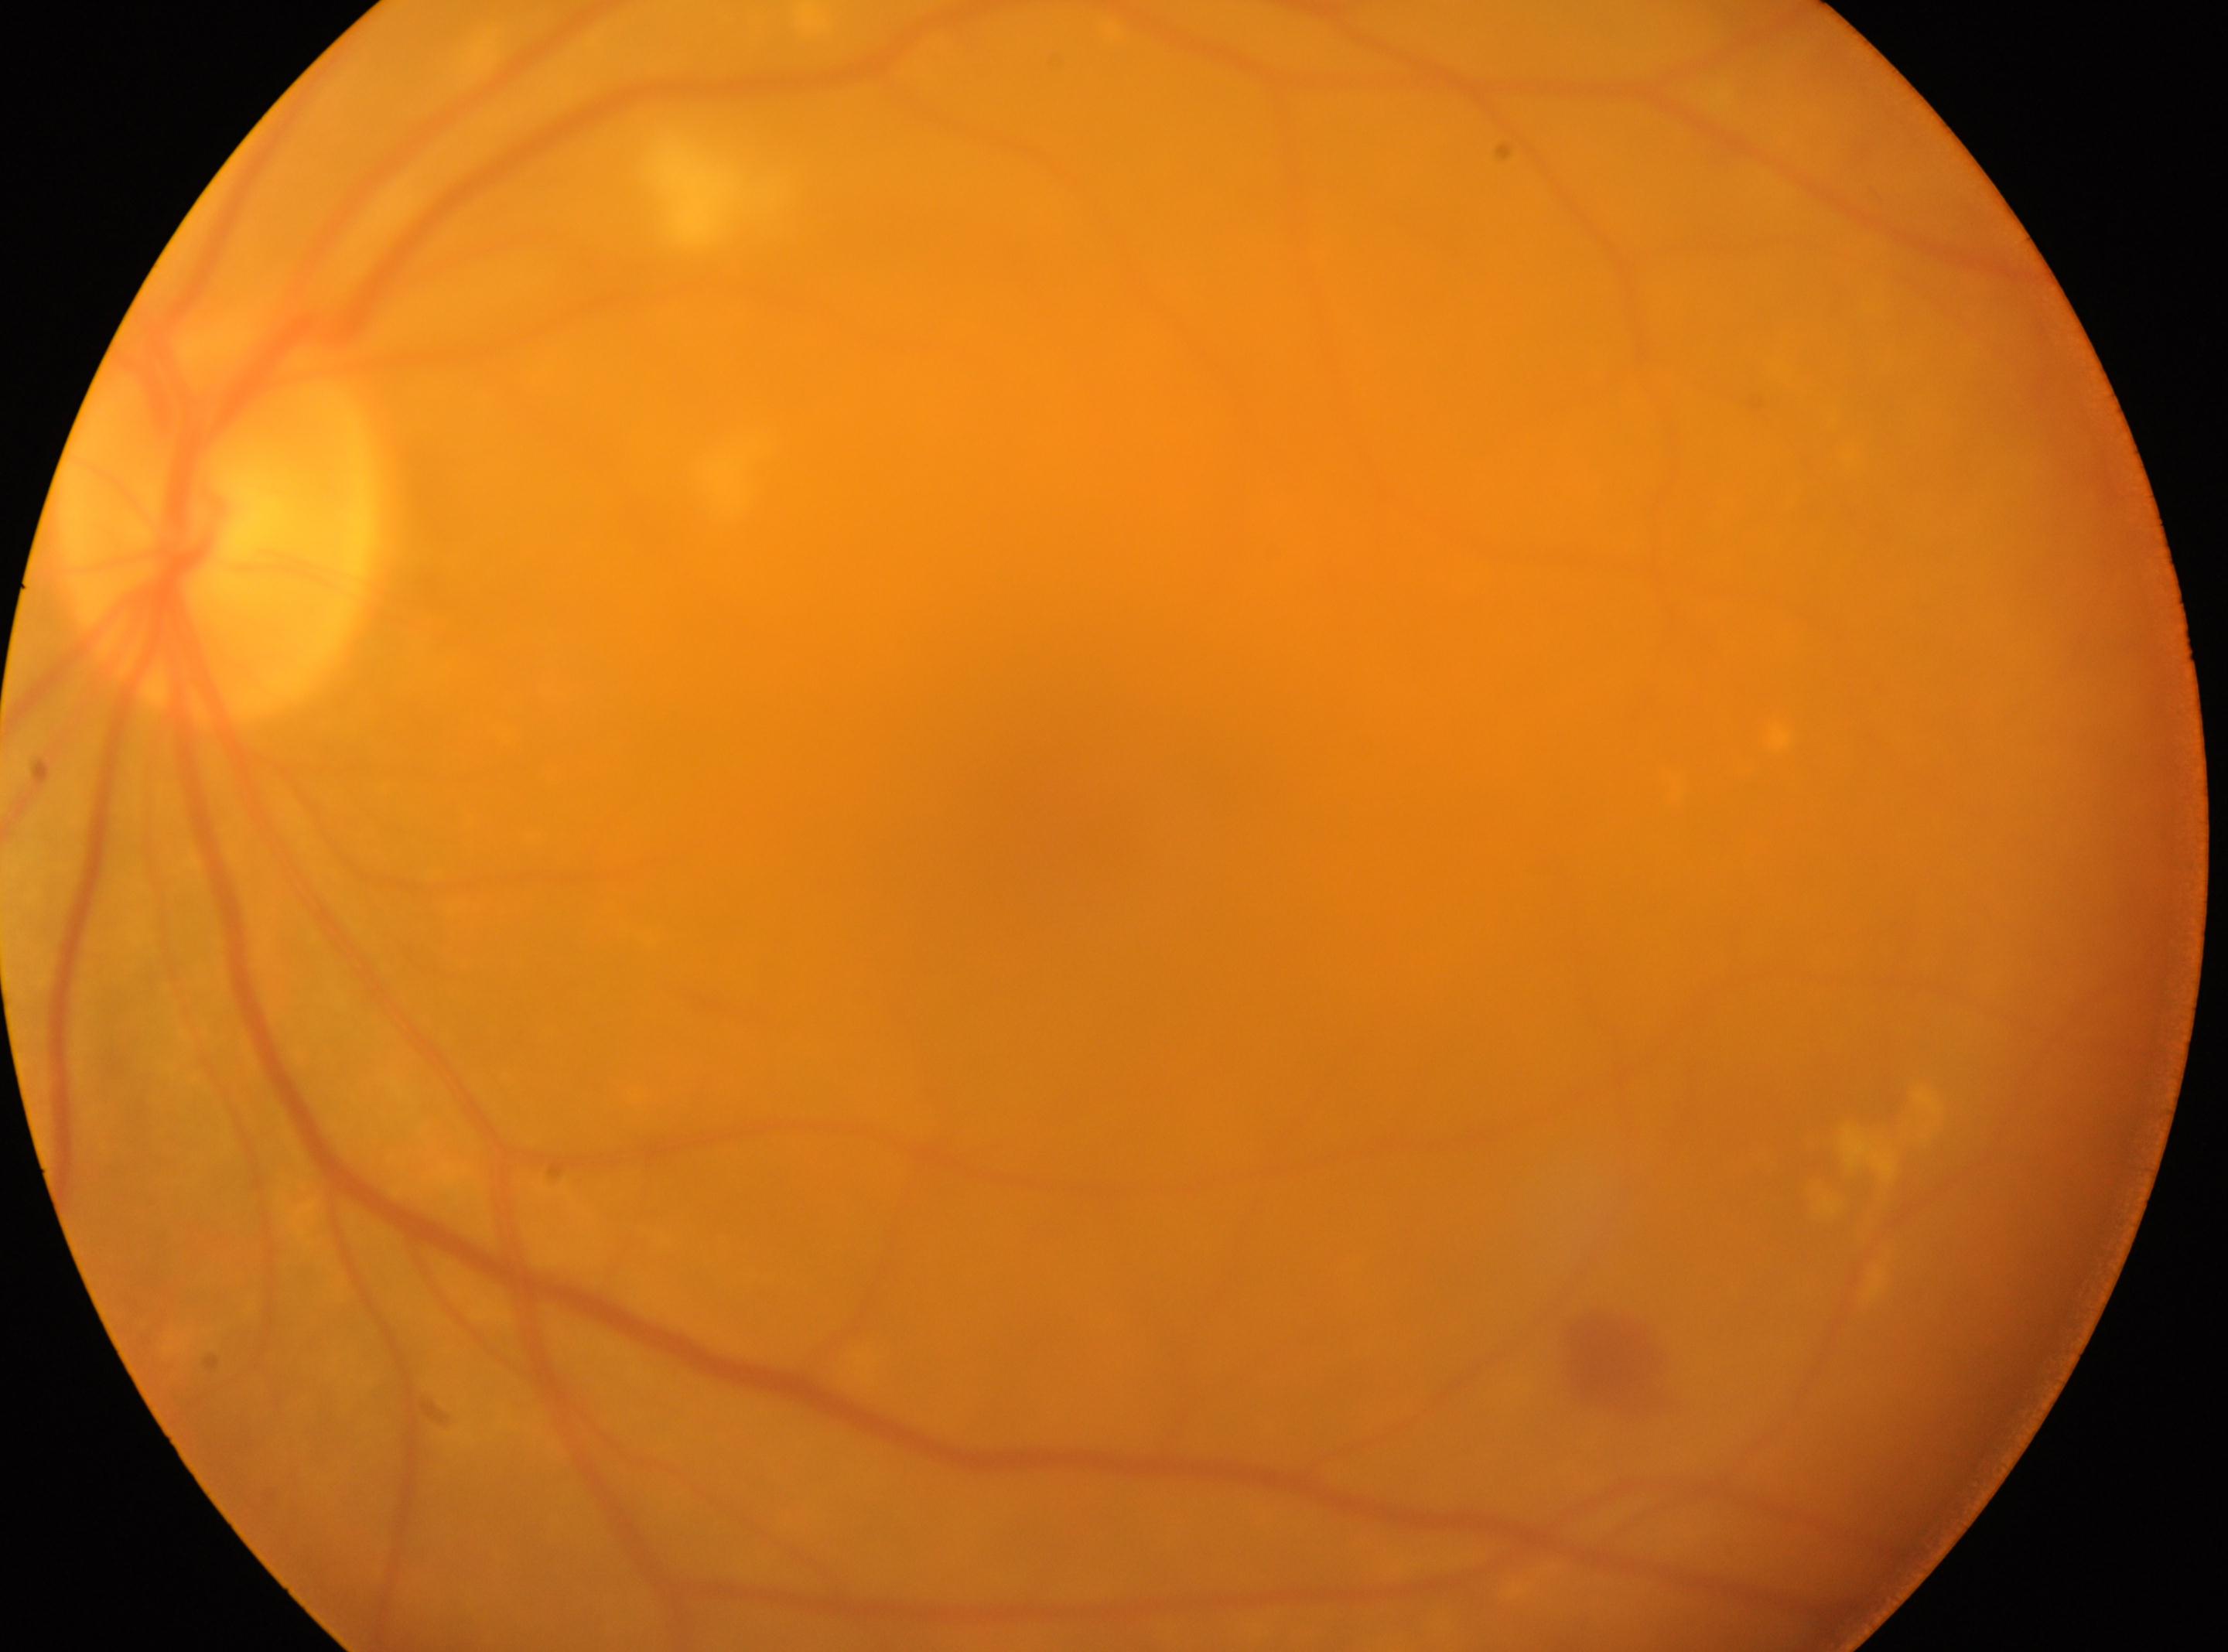

  eye: left eye
  fovea: (1068, 820)
  dr_grade: moderate non-proliferative diabetic retinopathy (grade 2)
  optic_disc: (220, 521)